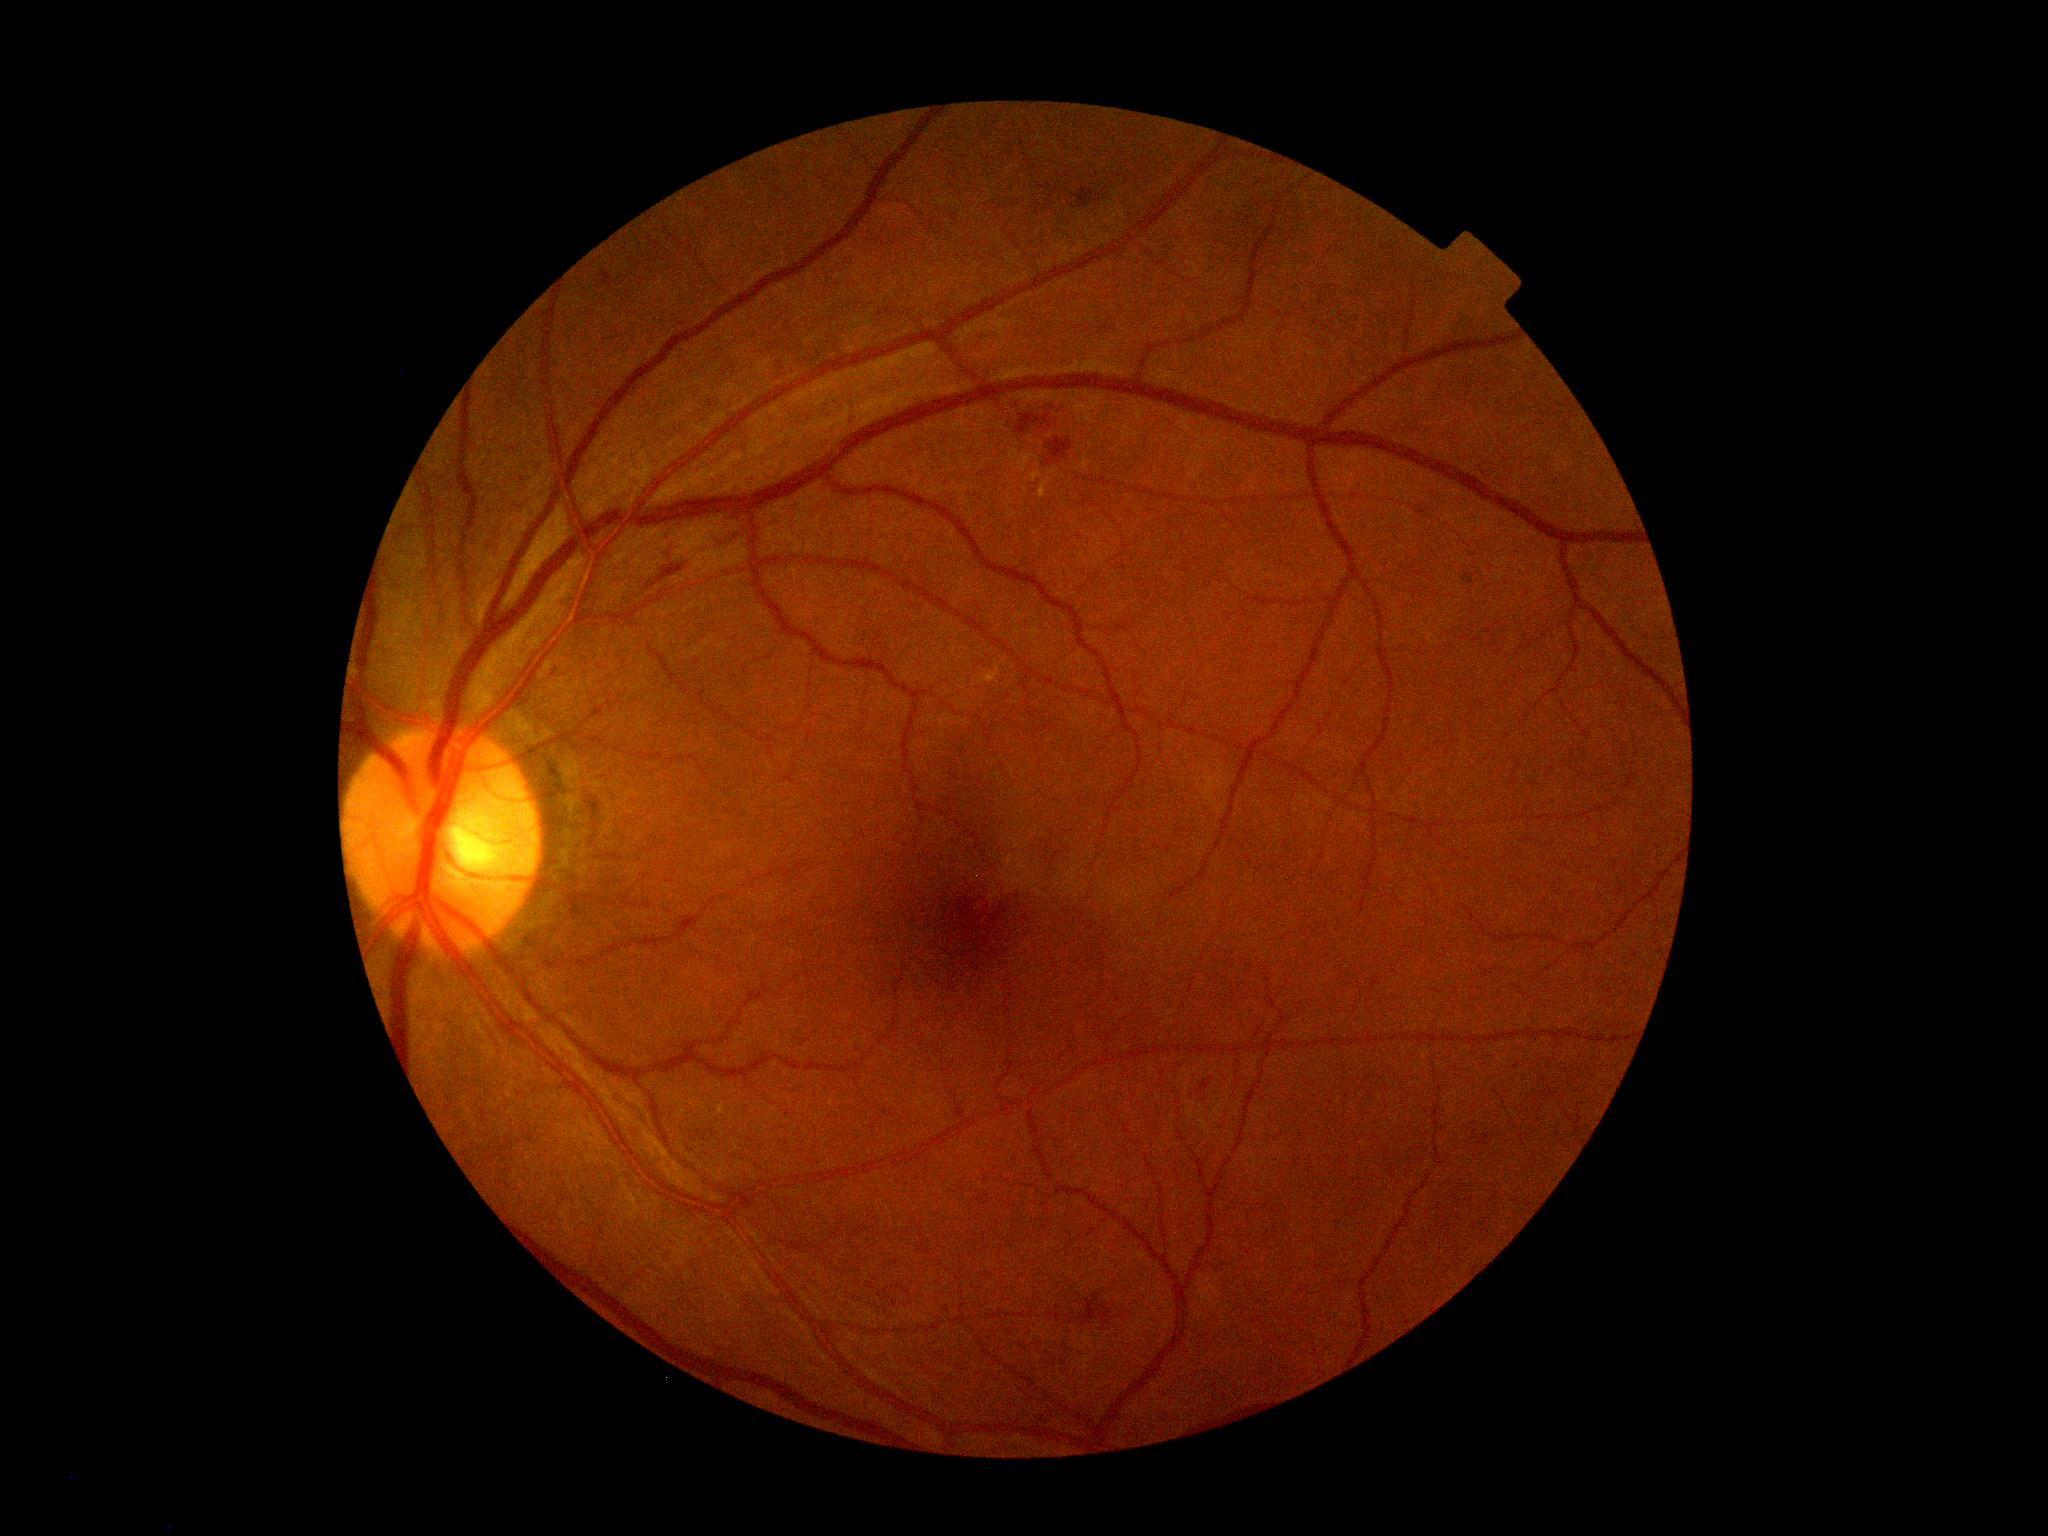
diabetic retinopathy = grade 2, DR class = non-proliferative diabetic retinopathy.